Graded on the modified Davis scale — 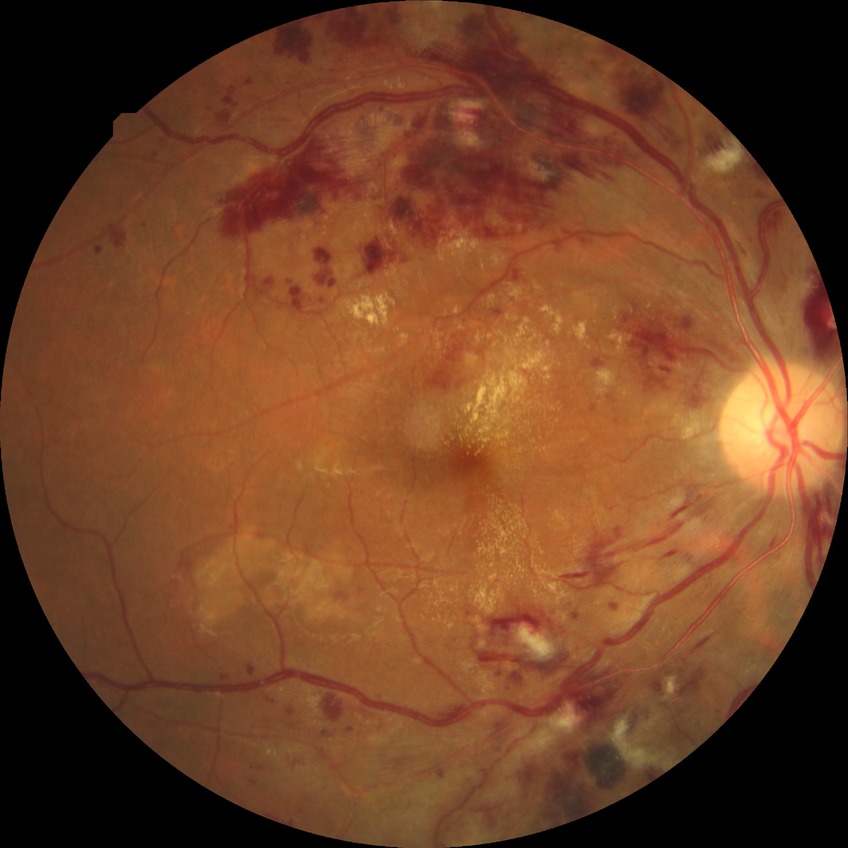

DR grade: PPDR.